Pediatric retinal photograph (wide-field). Captured with the Phoenix ICON (100° field of view). 1240x1240px.
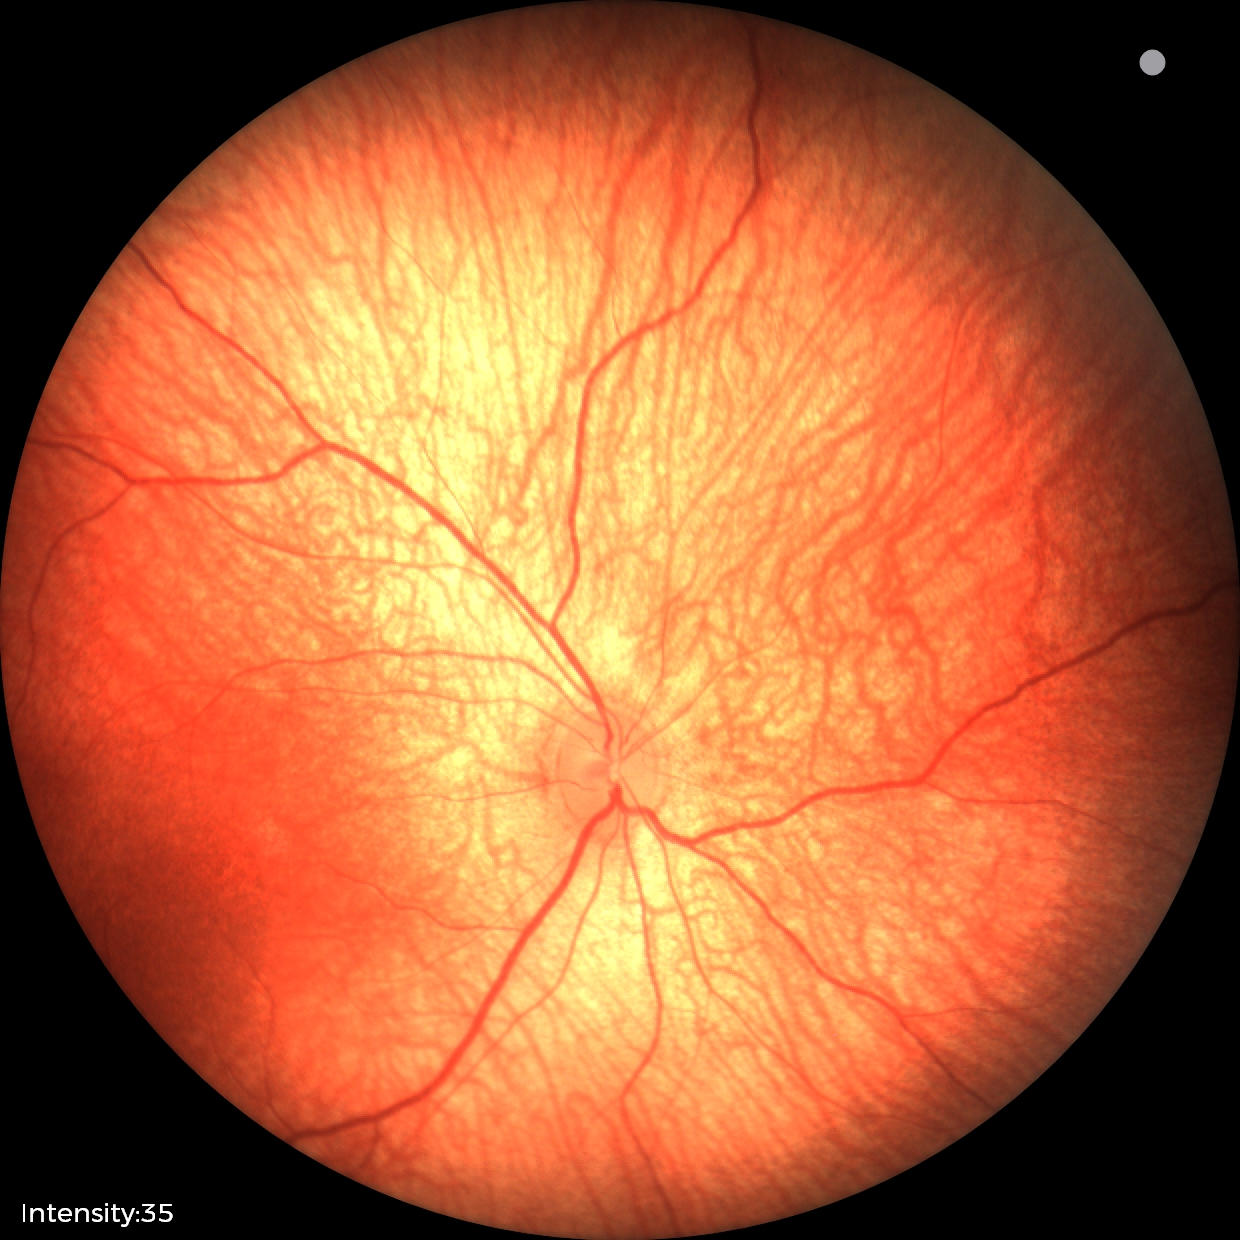

No retinal pathology identified on screening.